45° field of view.
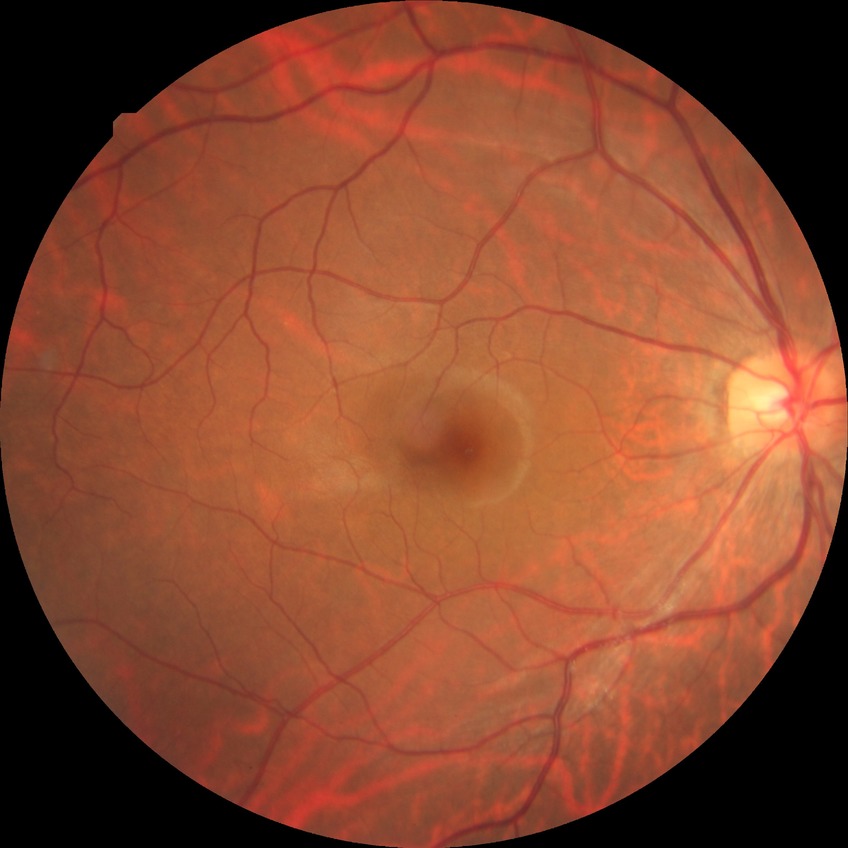
Davis grade is NDR.